45° field of view — 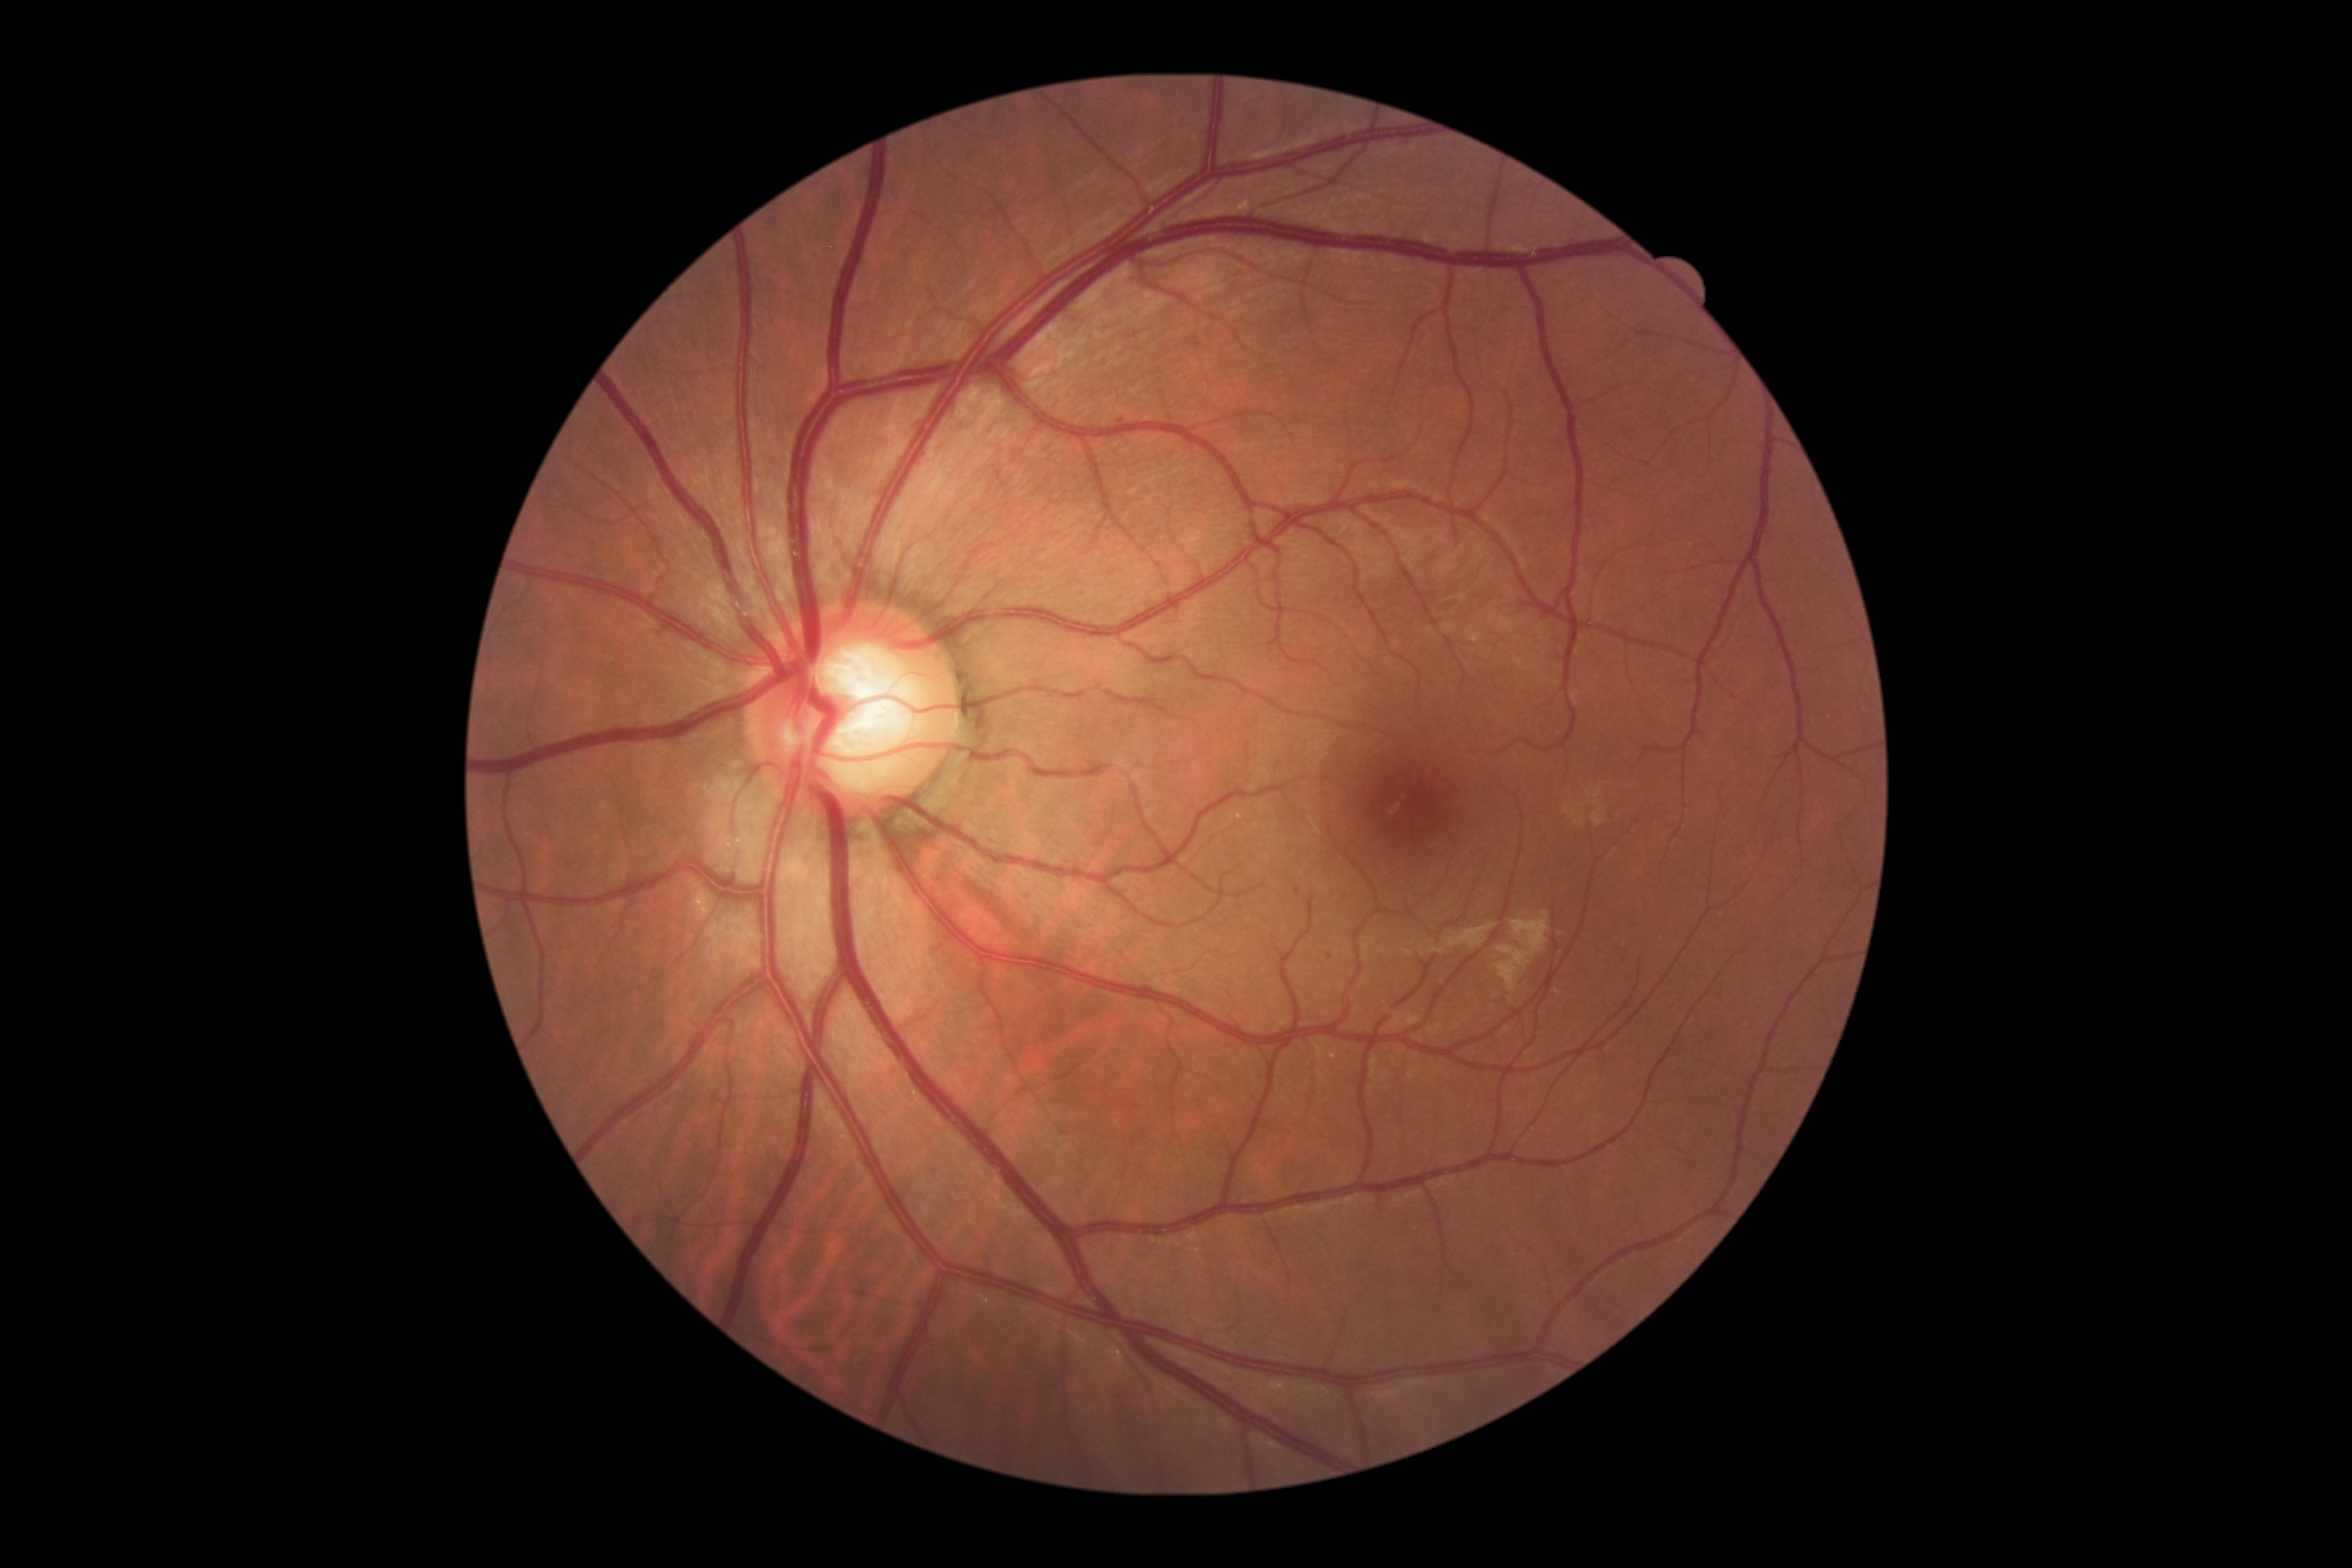

Diabetic retinopathy is 1
Lesions:
* microaneurysms: [1295, 888, 1300, 896]
* Small microaneurysms approximately at x=1329 y=957; x=1121 y=421
* soft exudates: not present
* hard exudates: not present
* hemorrhages: not present